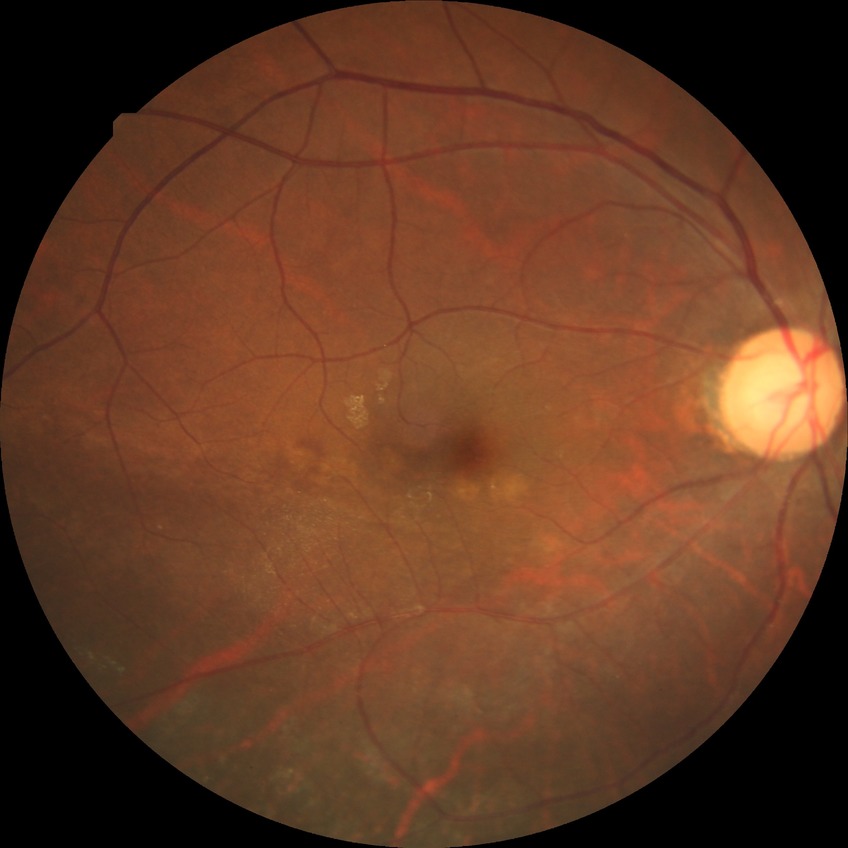
Diabetic retinopathy (DR): NDR (no diabetic retinopathy).